Handheld portable fundus camera image. FOV: 60 degrees — 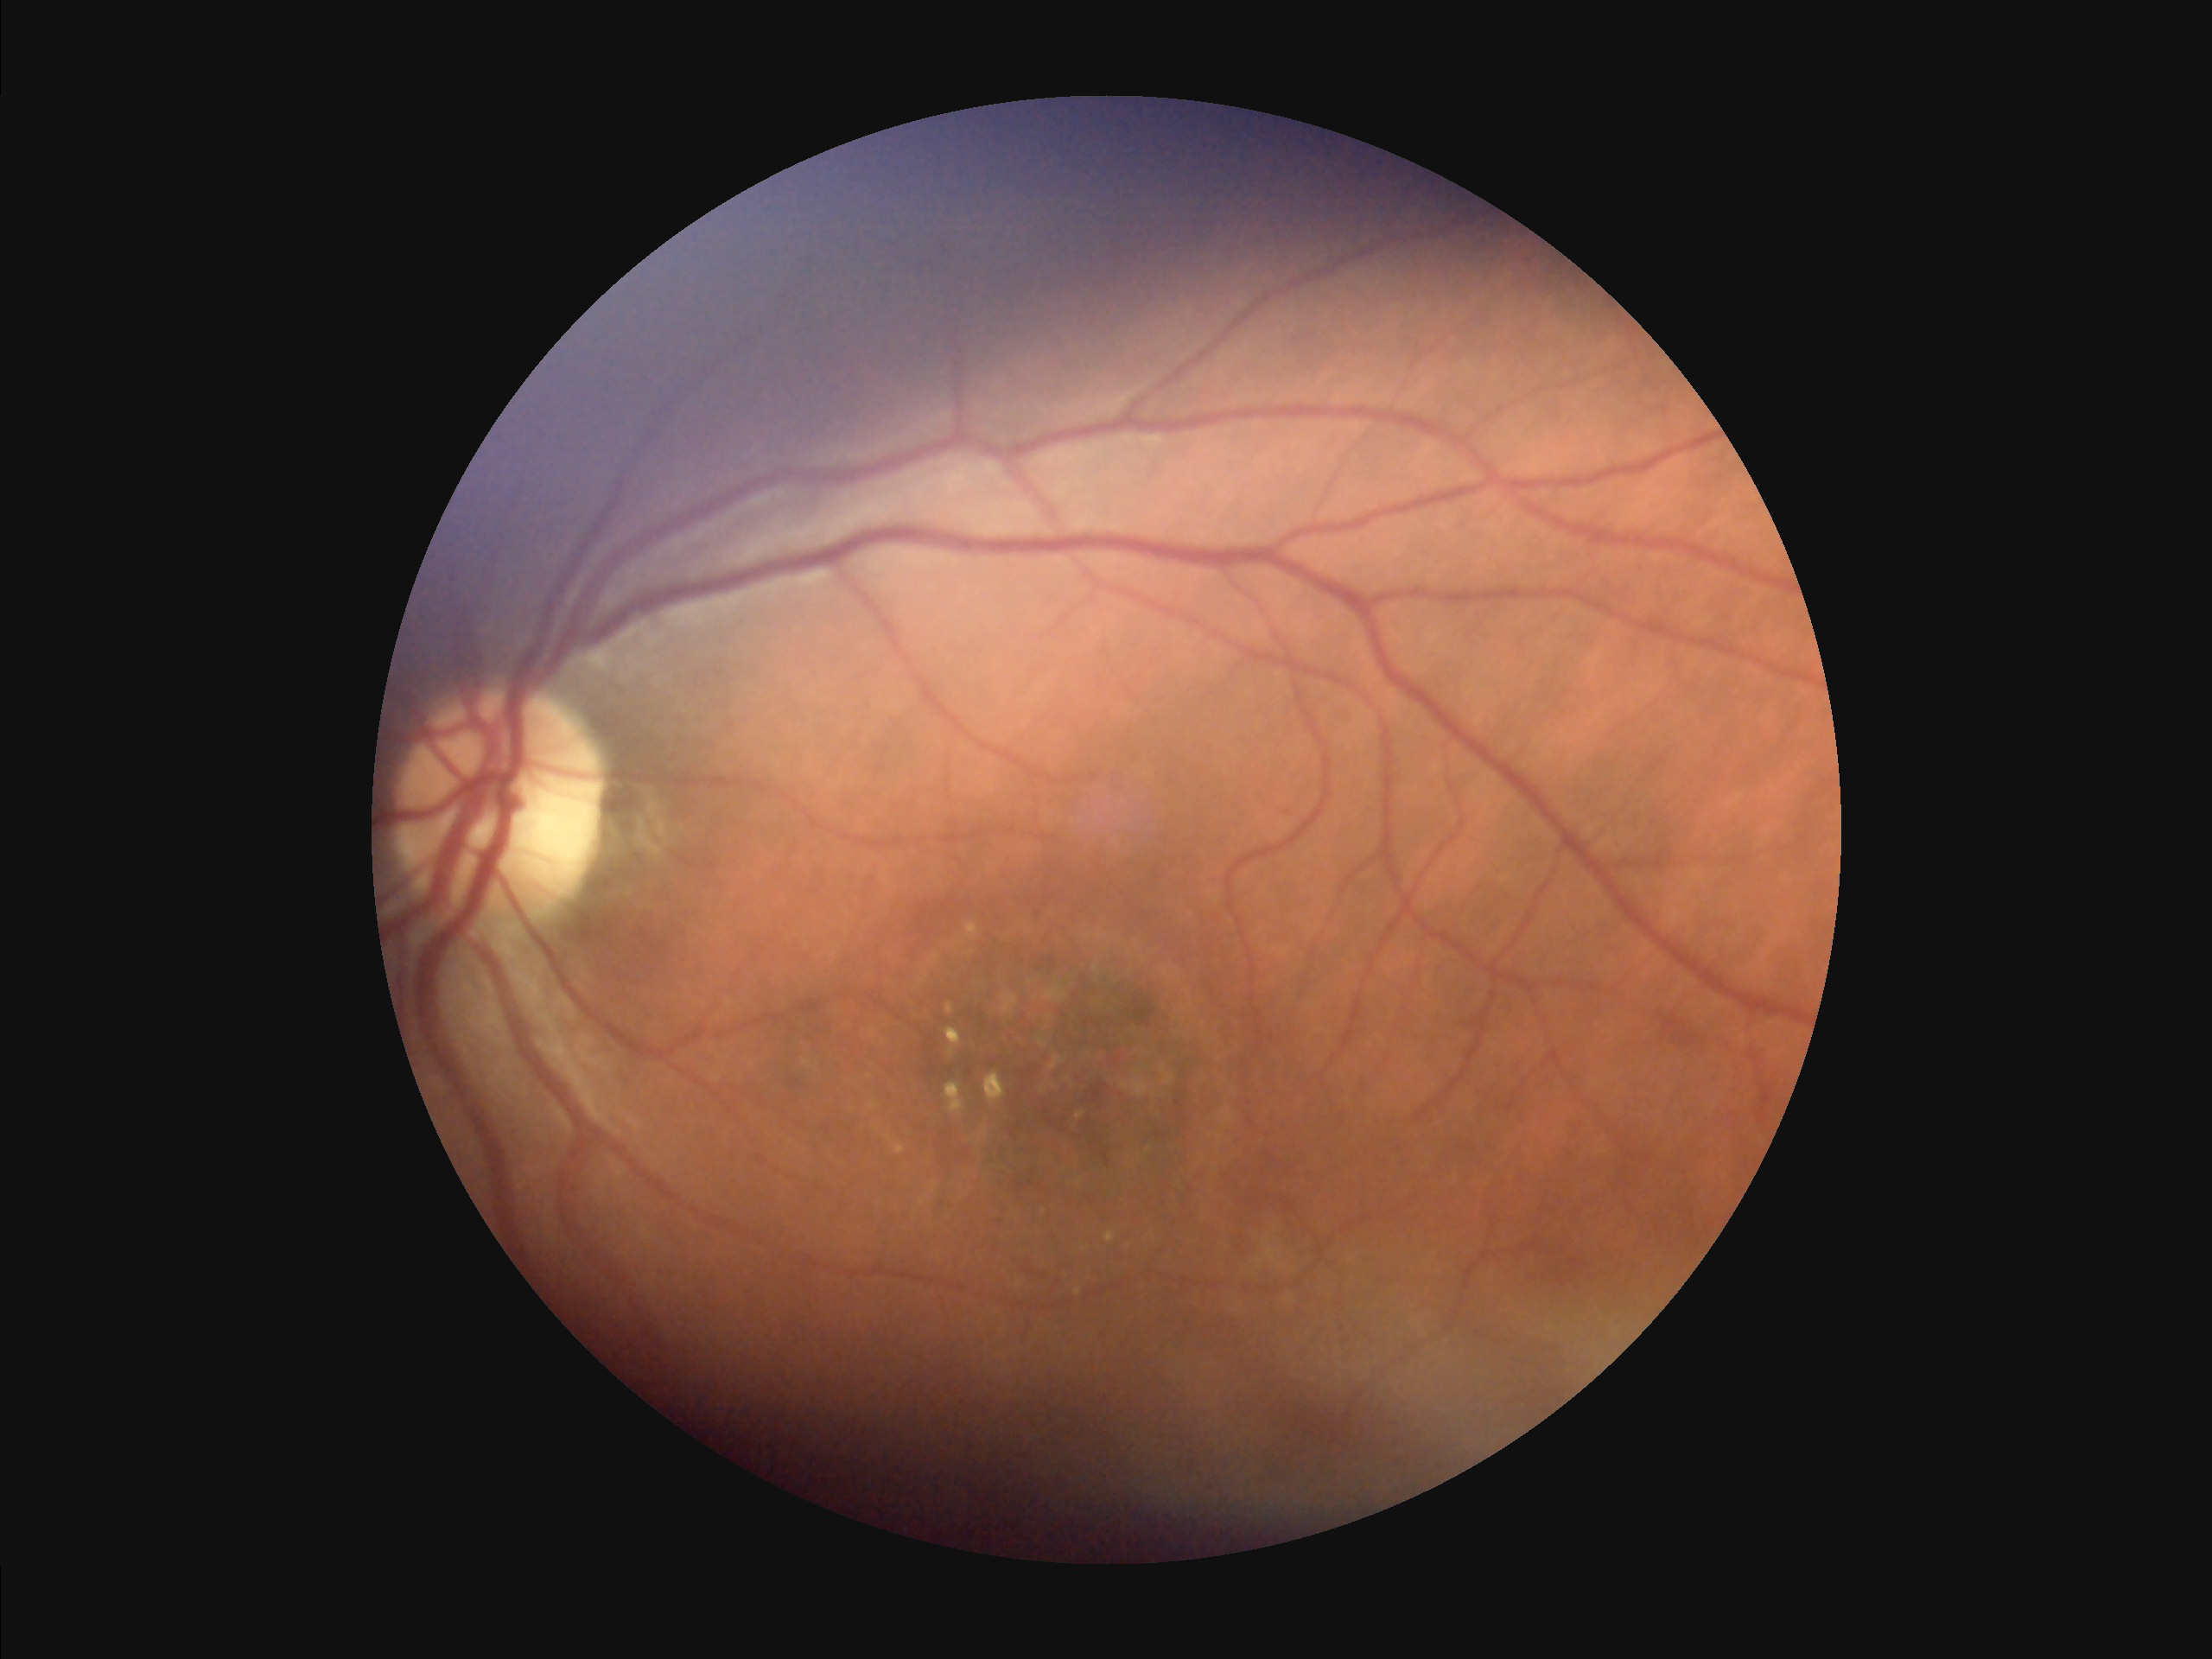 The image is clear. Vessels and details are readily distinguishable. There is over- or under-exposure or a color cast. Acceptable image quality.